Pediatric wide-field fundus photograph:
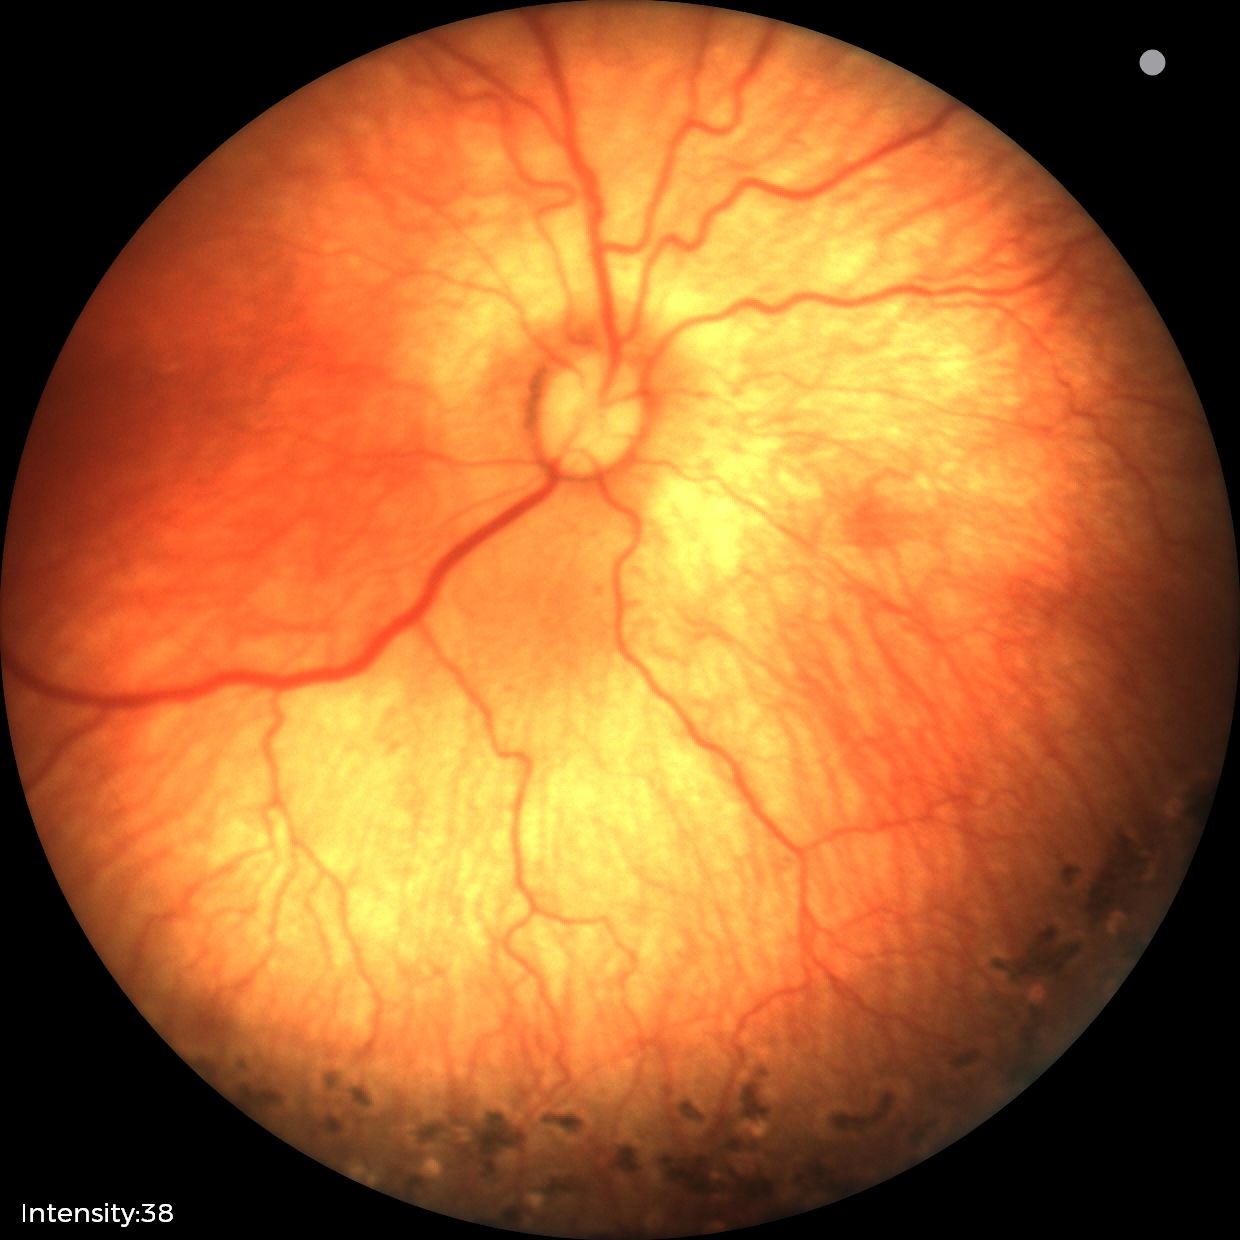 Q: What was the screening finding?
A: status post ROP — retinal appearance after treated retinopathy of prematurity
Q: What is the plus-form classification?
A: no plus disease